Posterior pole photograph. 848x848: 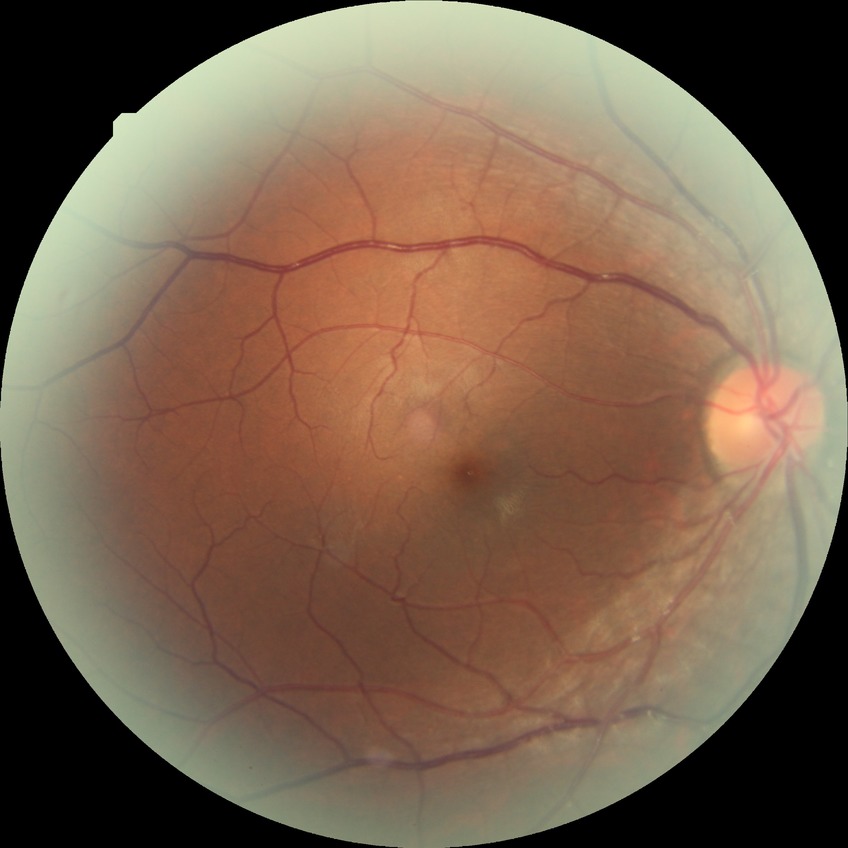

Modified Davis grading: no diabetic retinopathy.